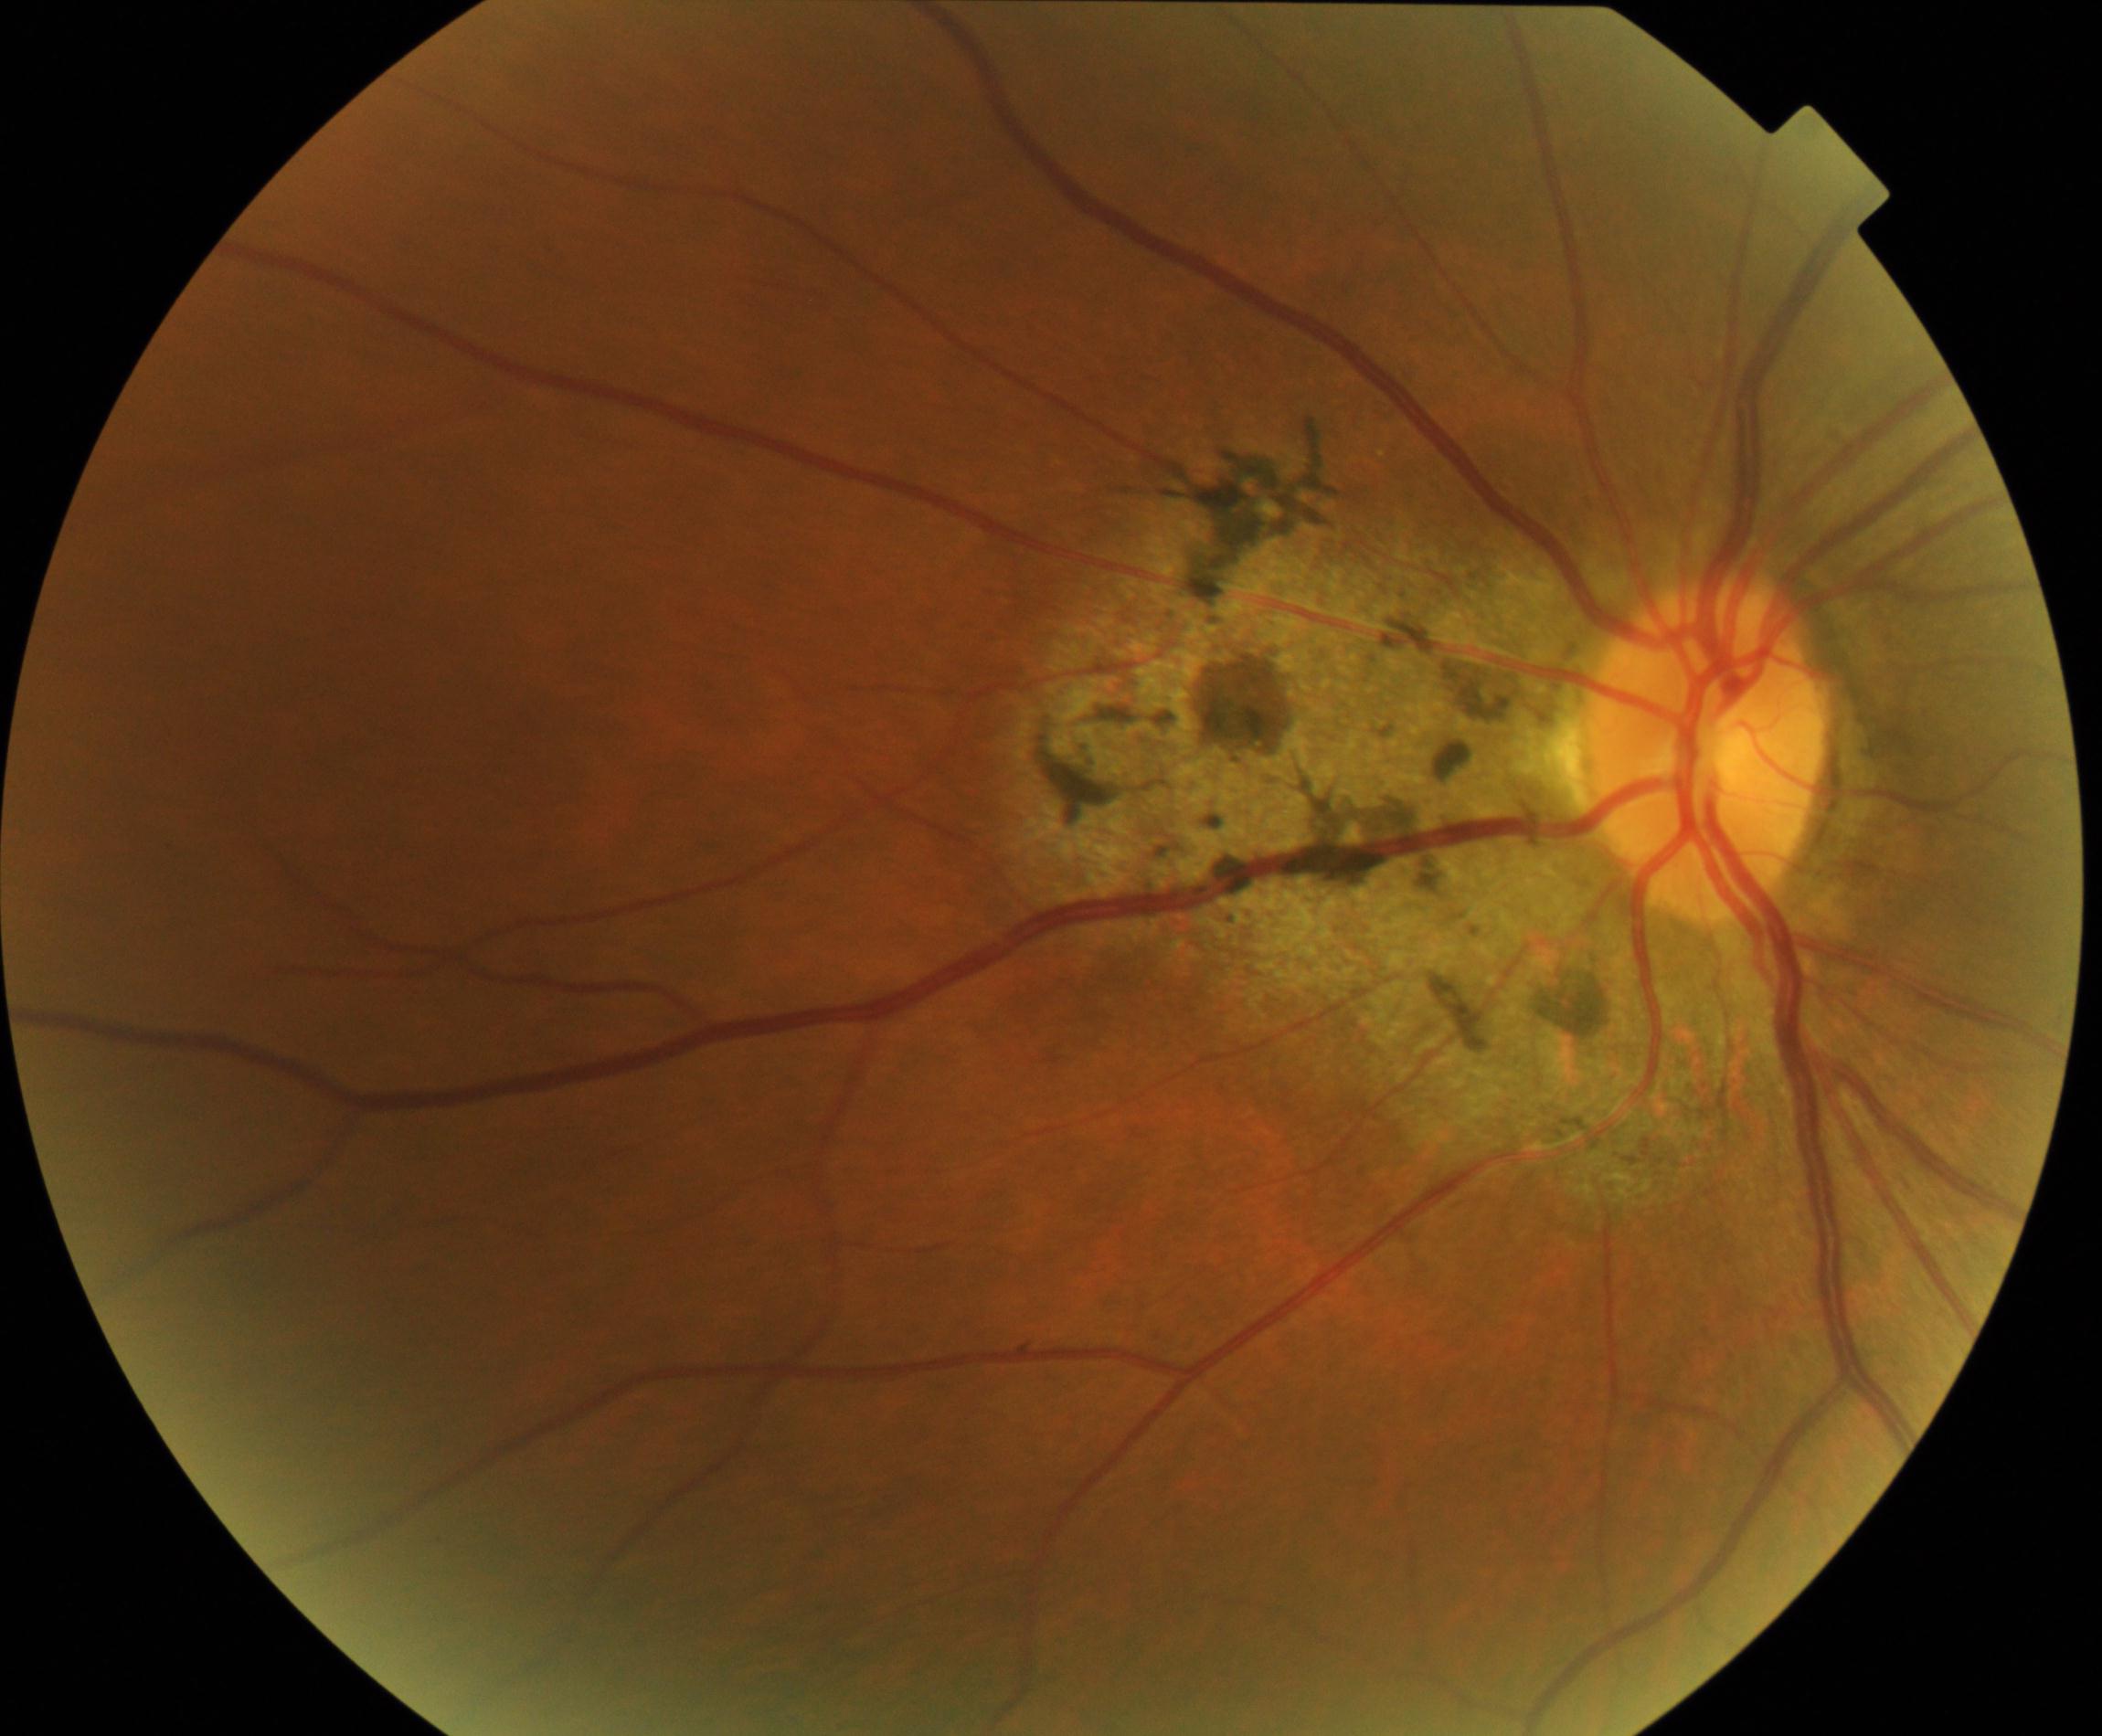 There is evidence of chorioretinal atrophy or coloboma.